Infant wide-field fundus photograph — 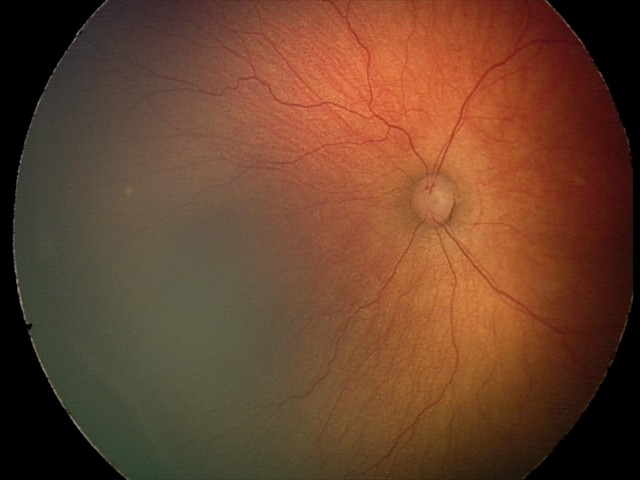
Diagnosis: ROP stage 2, plus disease: absent.